Diabetic retinopathy graded by the modified Davis classification:
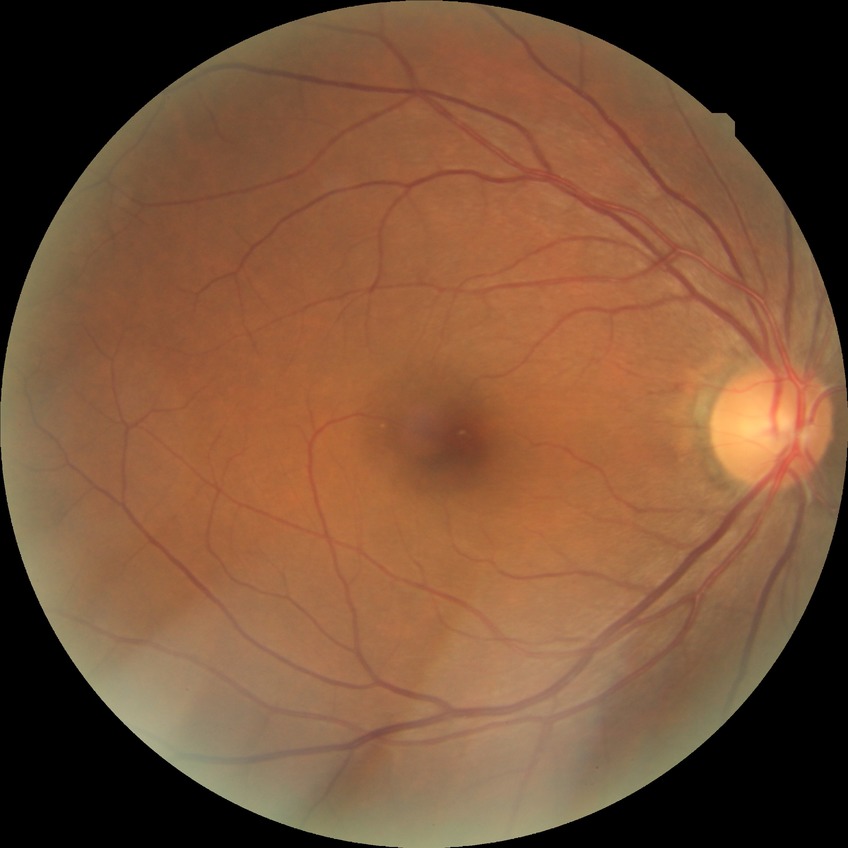 DR impression = no apparent DR, Davis stage = NDR.